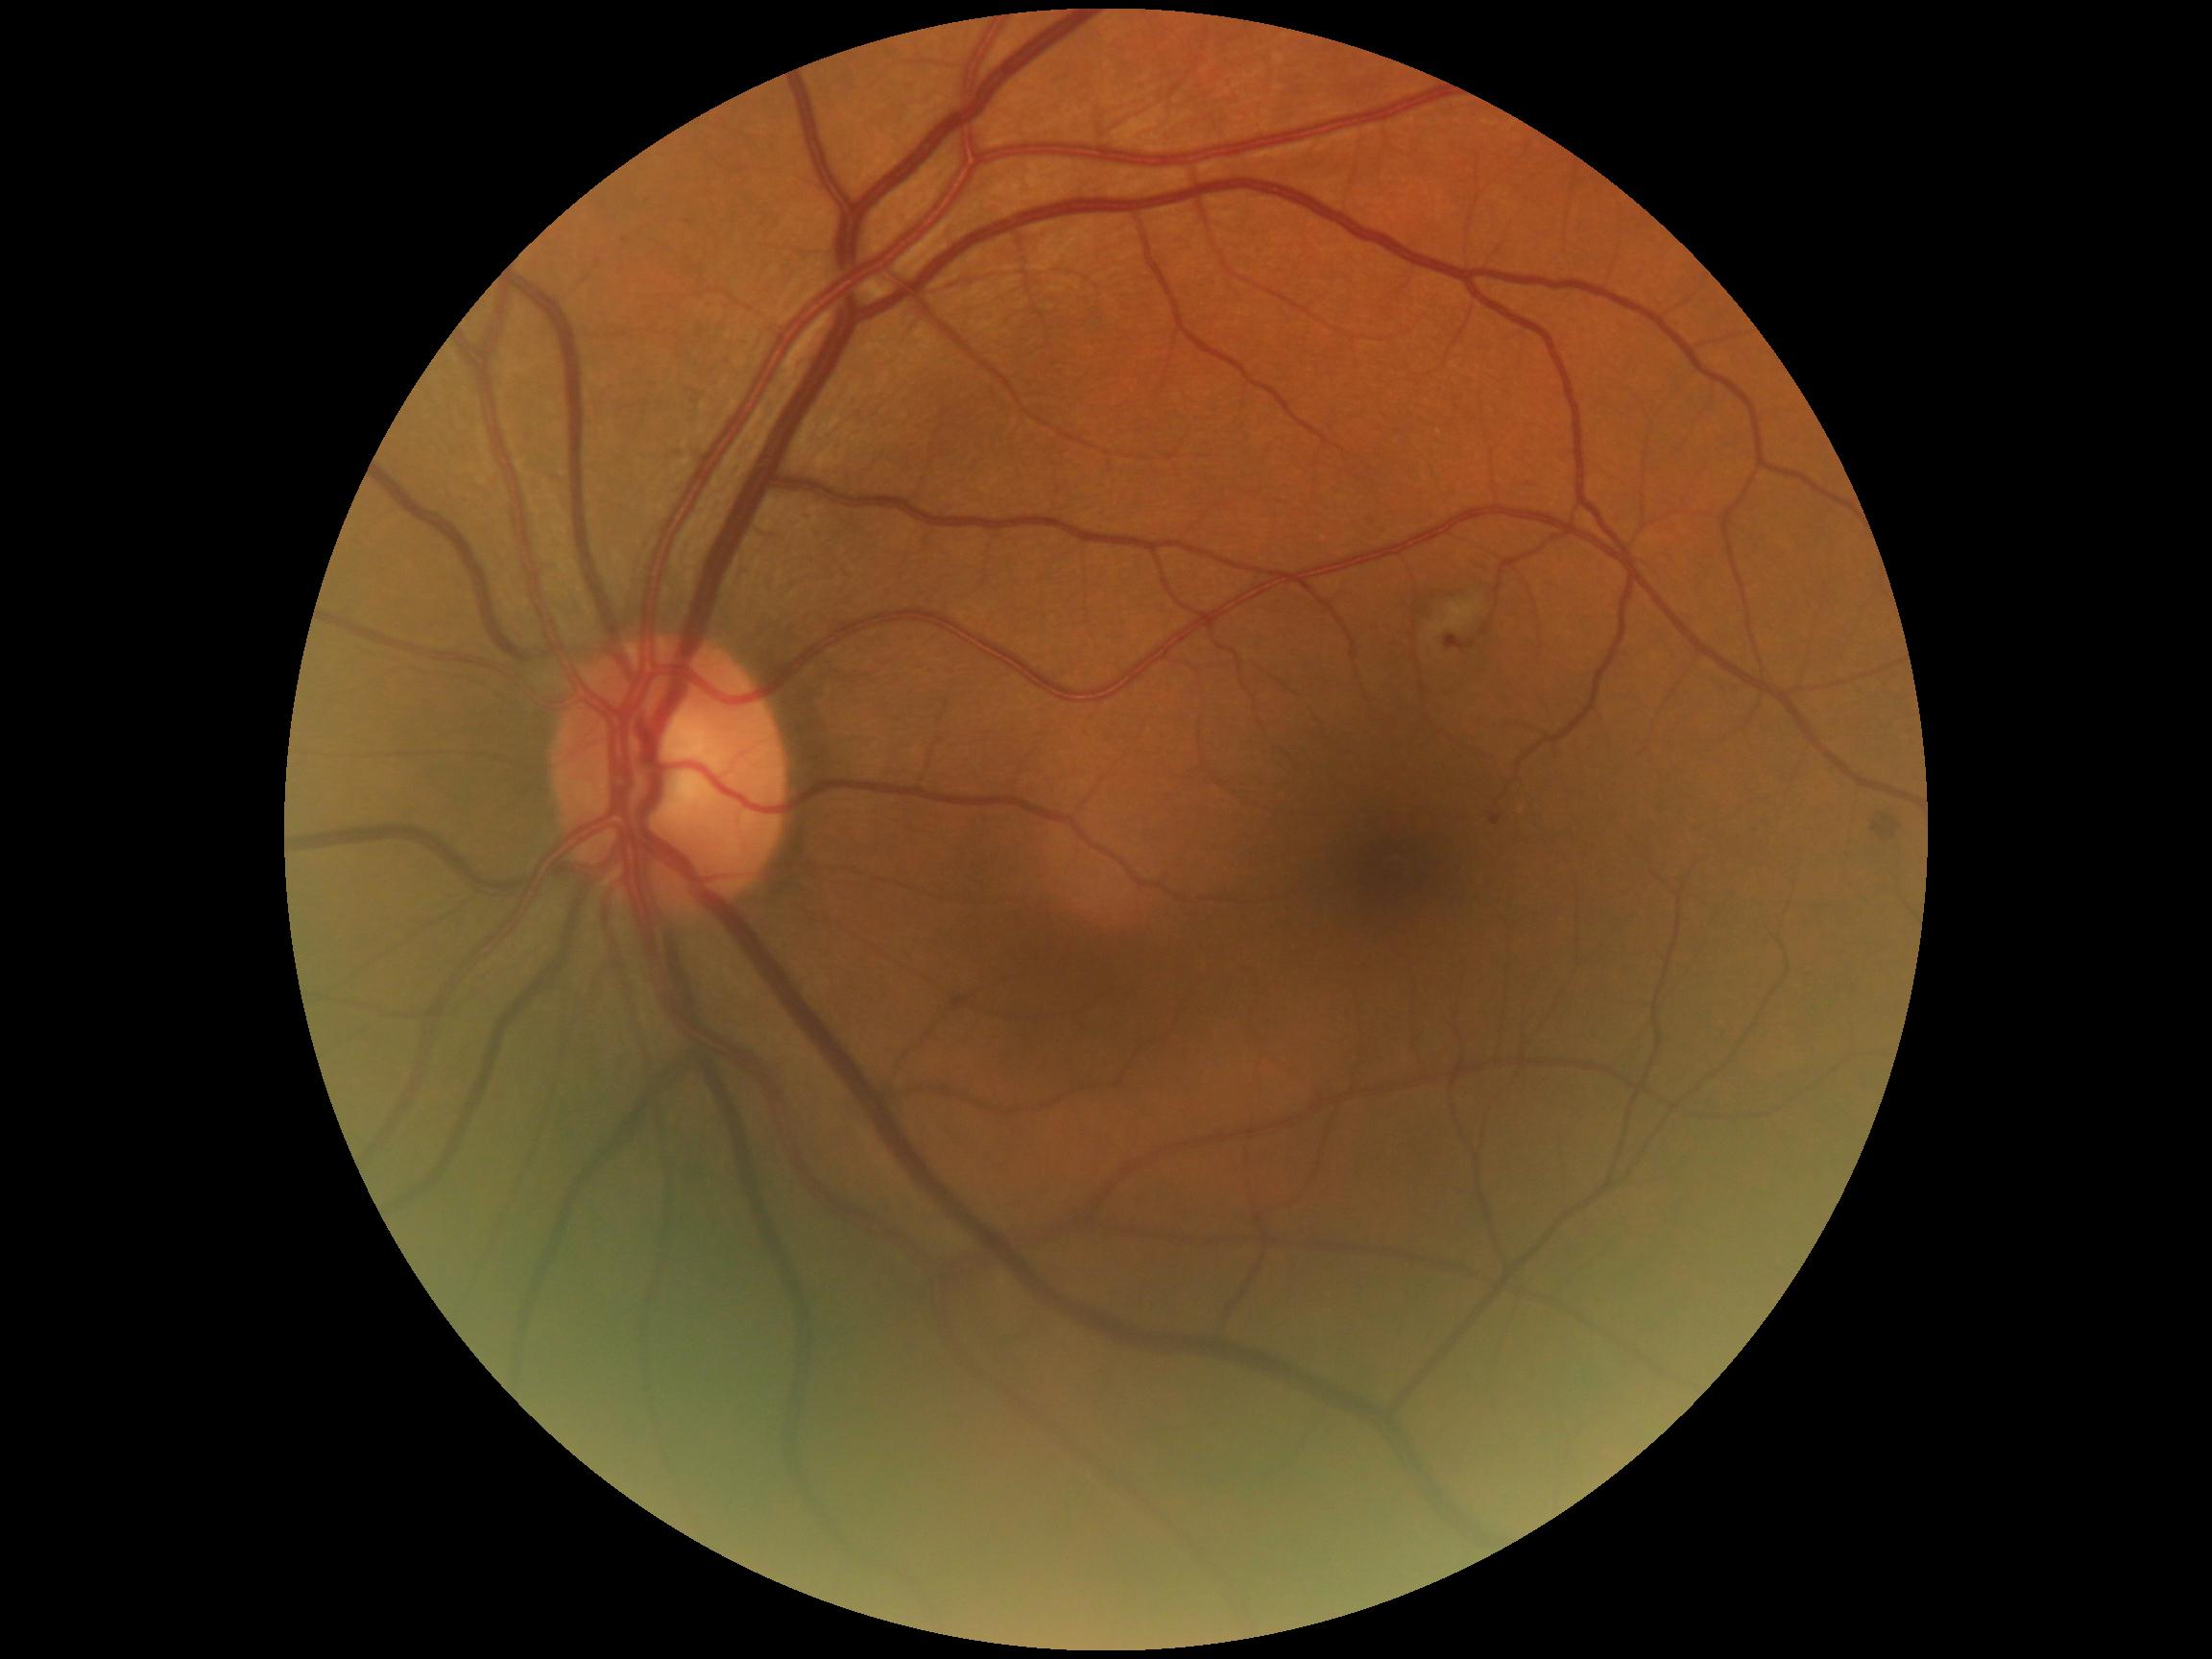
Diabetic retinopathy severity is grade 2.